CFP · acquired with a Topcon TRC-NW8
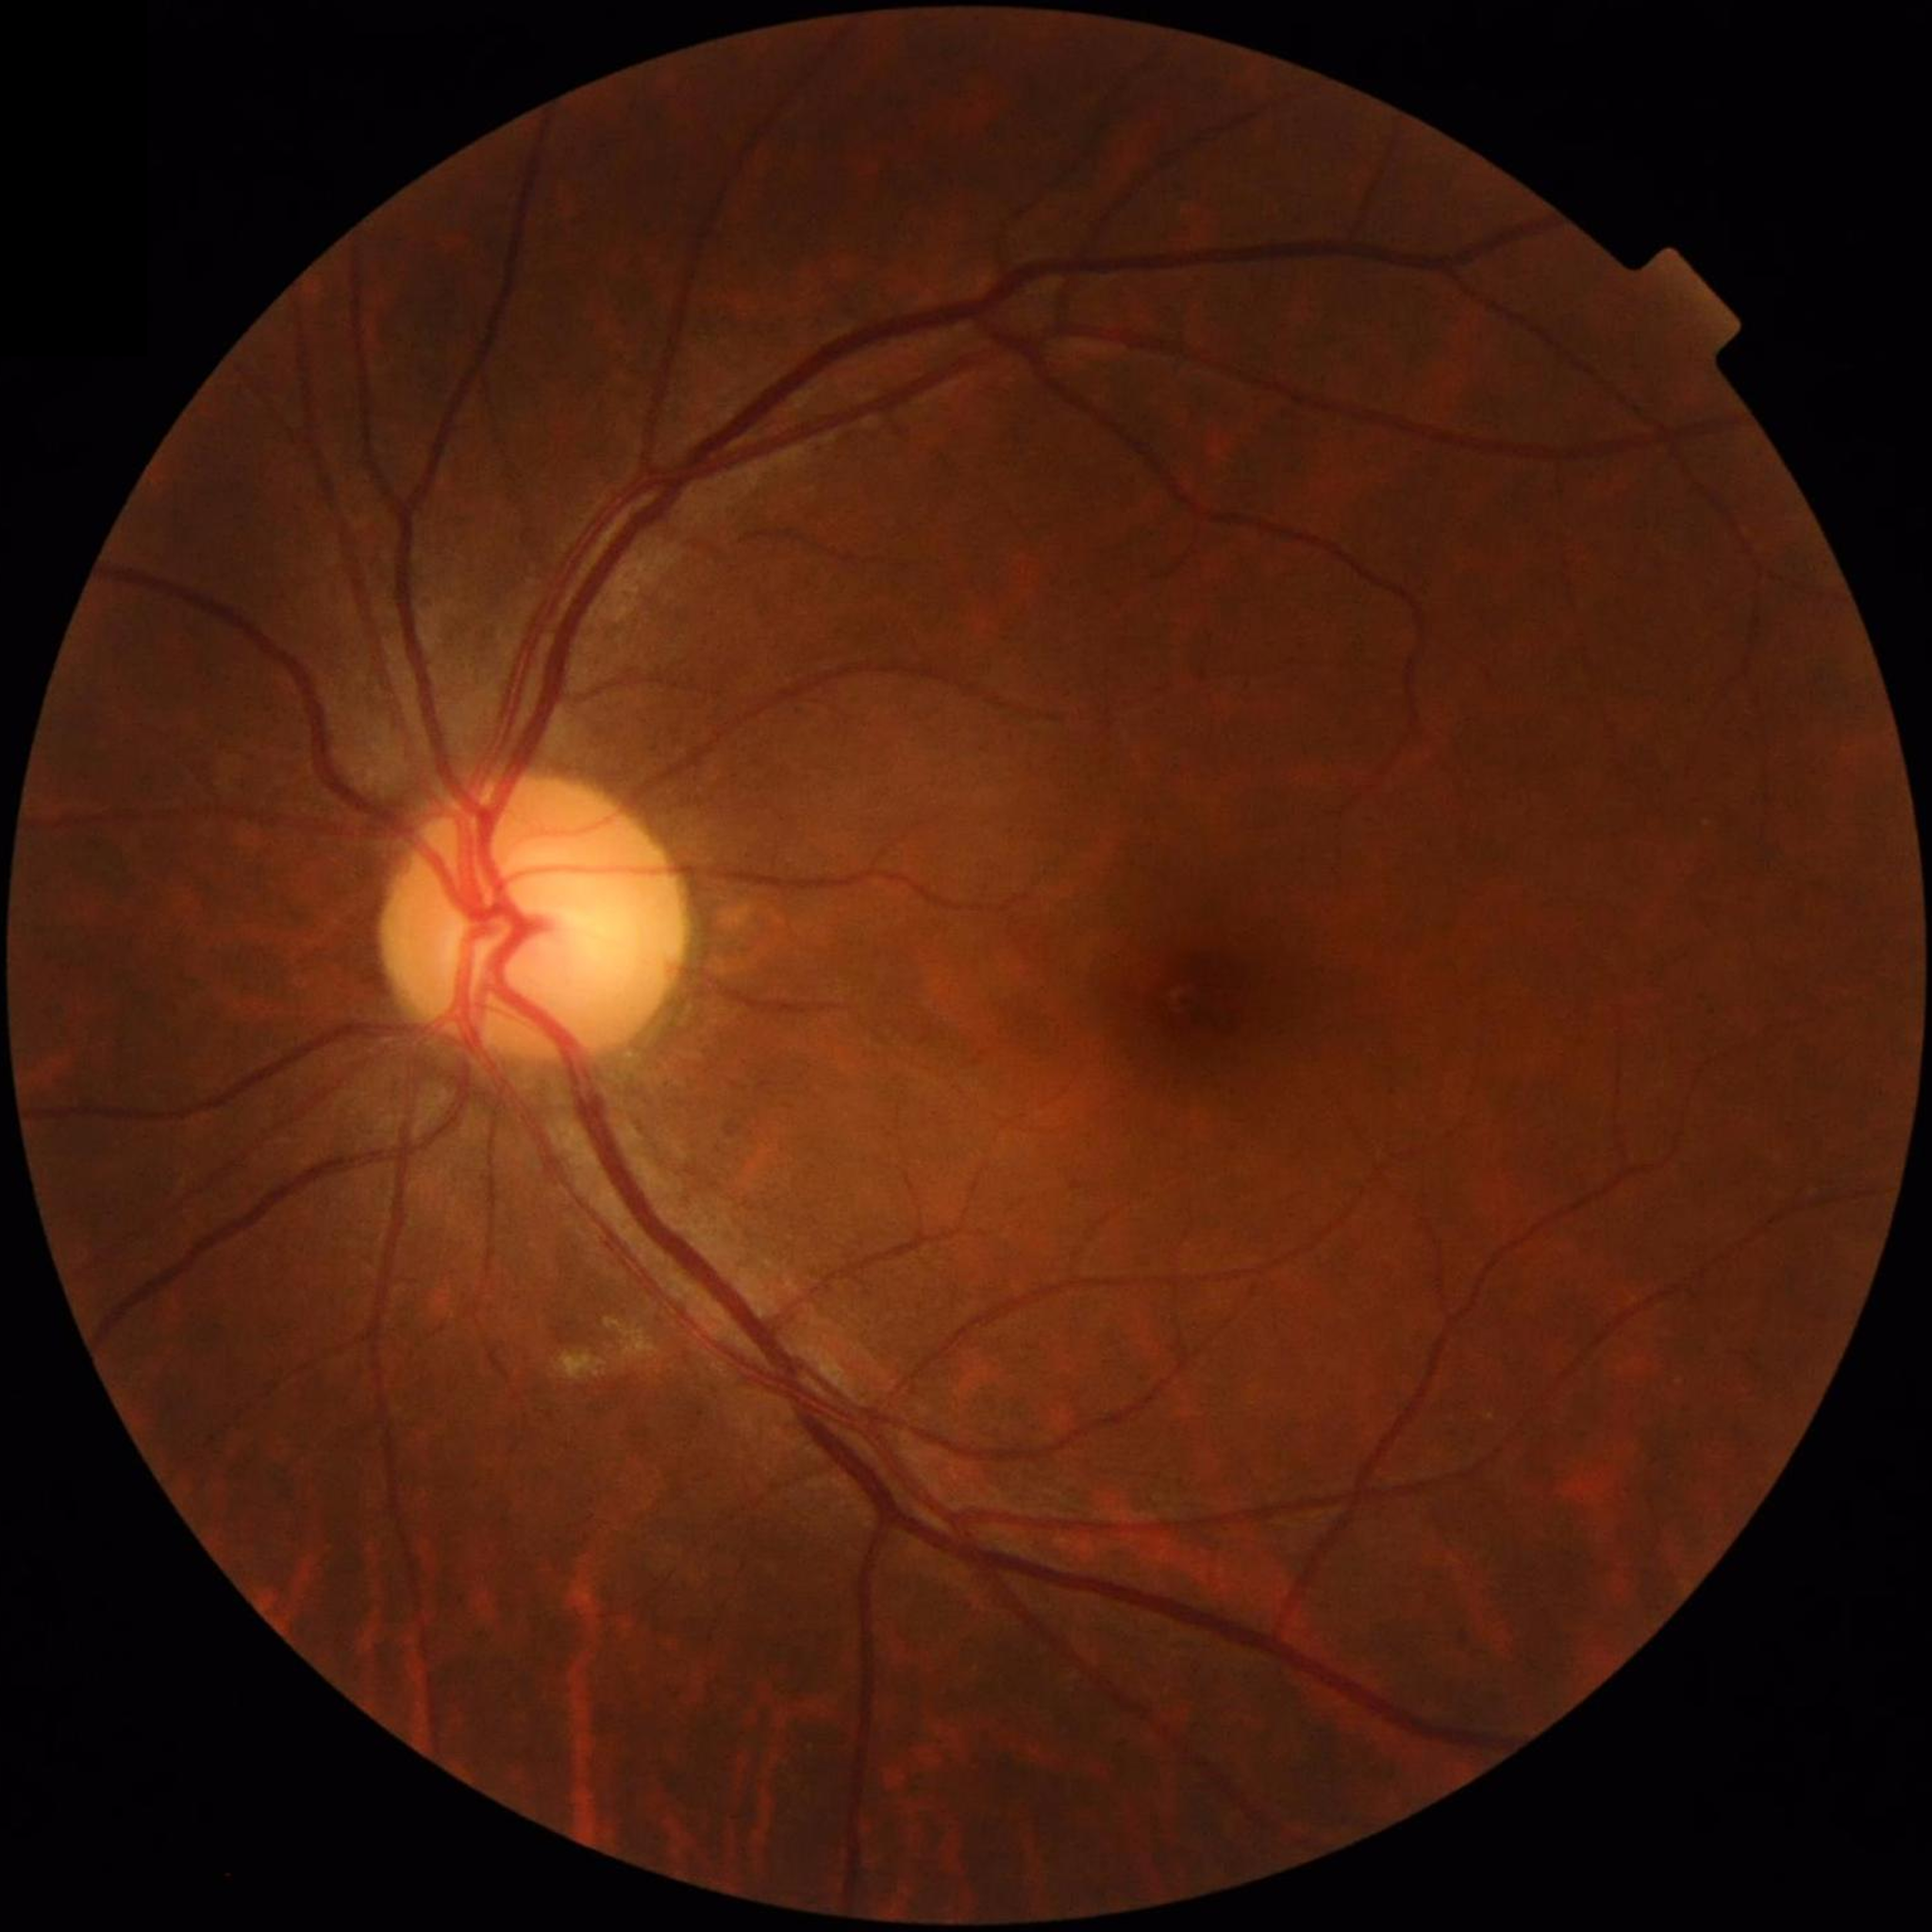
Clinical diagnosis = no AMD, diabetic retinopathy, or glaucoma.